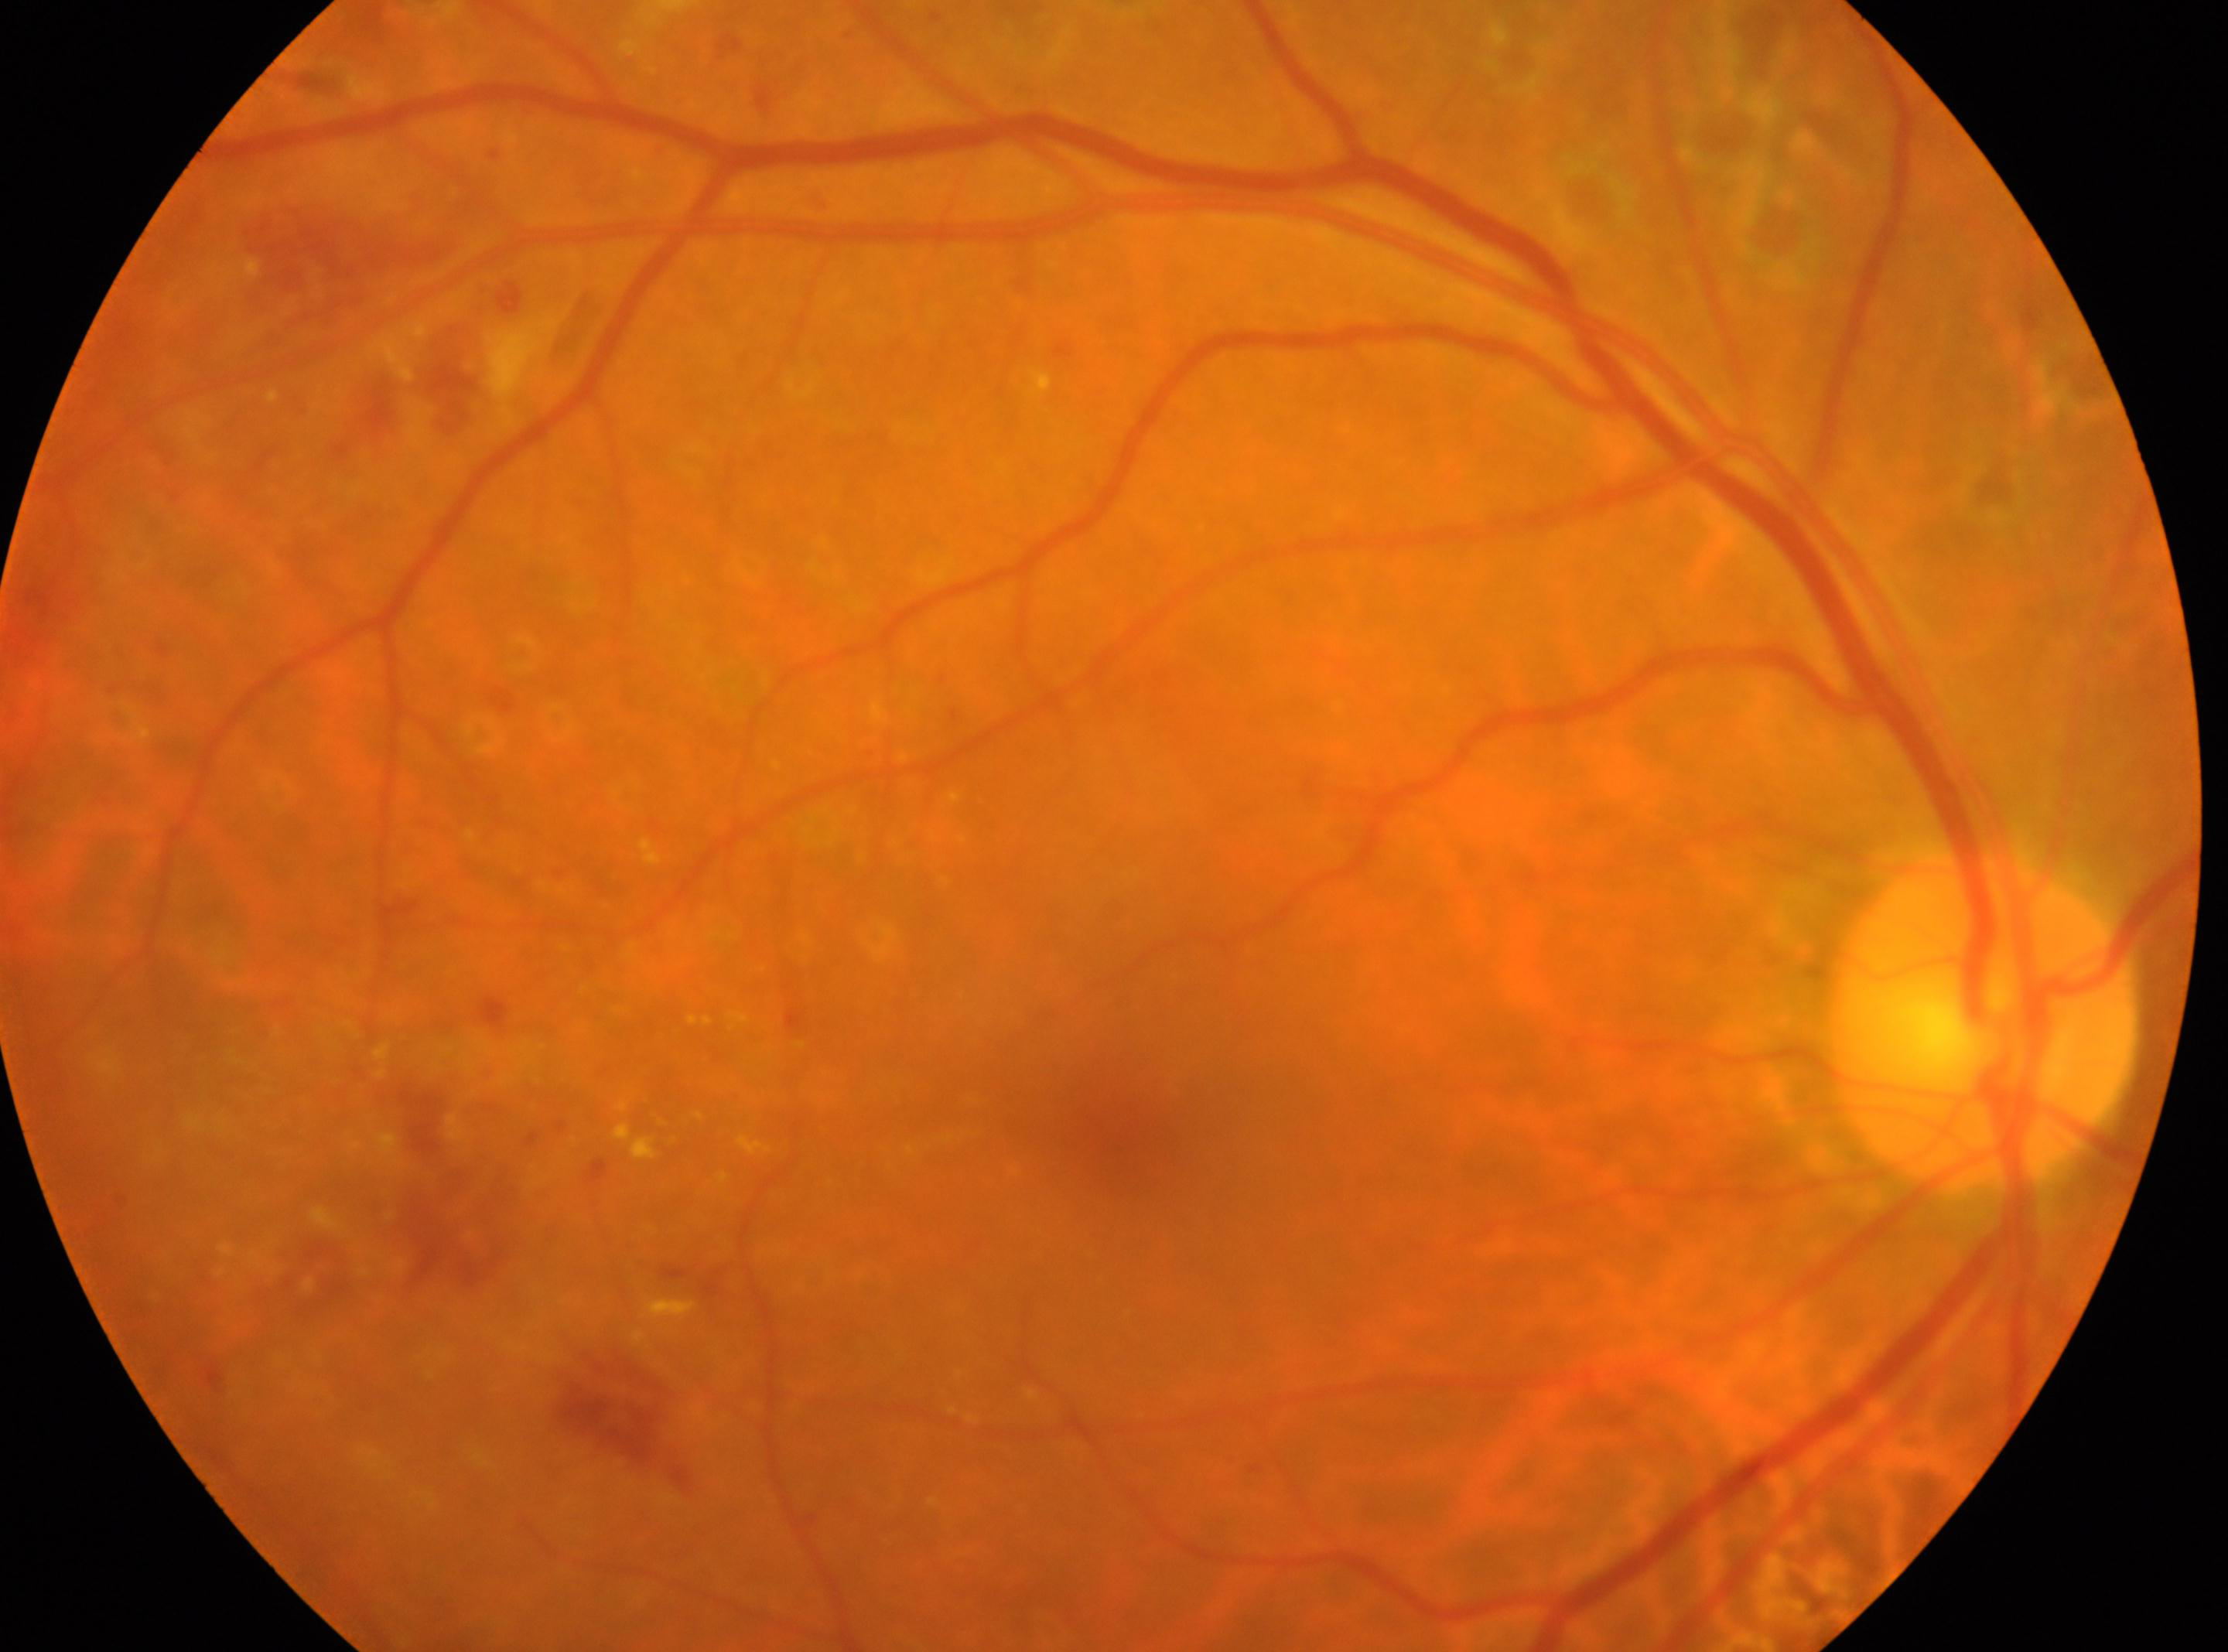

the fovea = 1128px, 1151px | optic nerve head = 1984px, 1022px | eye = OD | DR grade = DR with laser spots or scars, with underlying moderate NPDR (grade 2).